Fundus photo; 45° FOV; 2212x1672px:
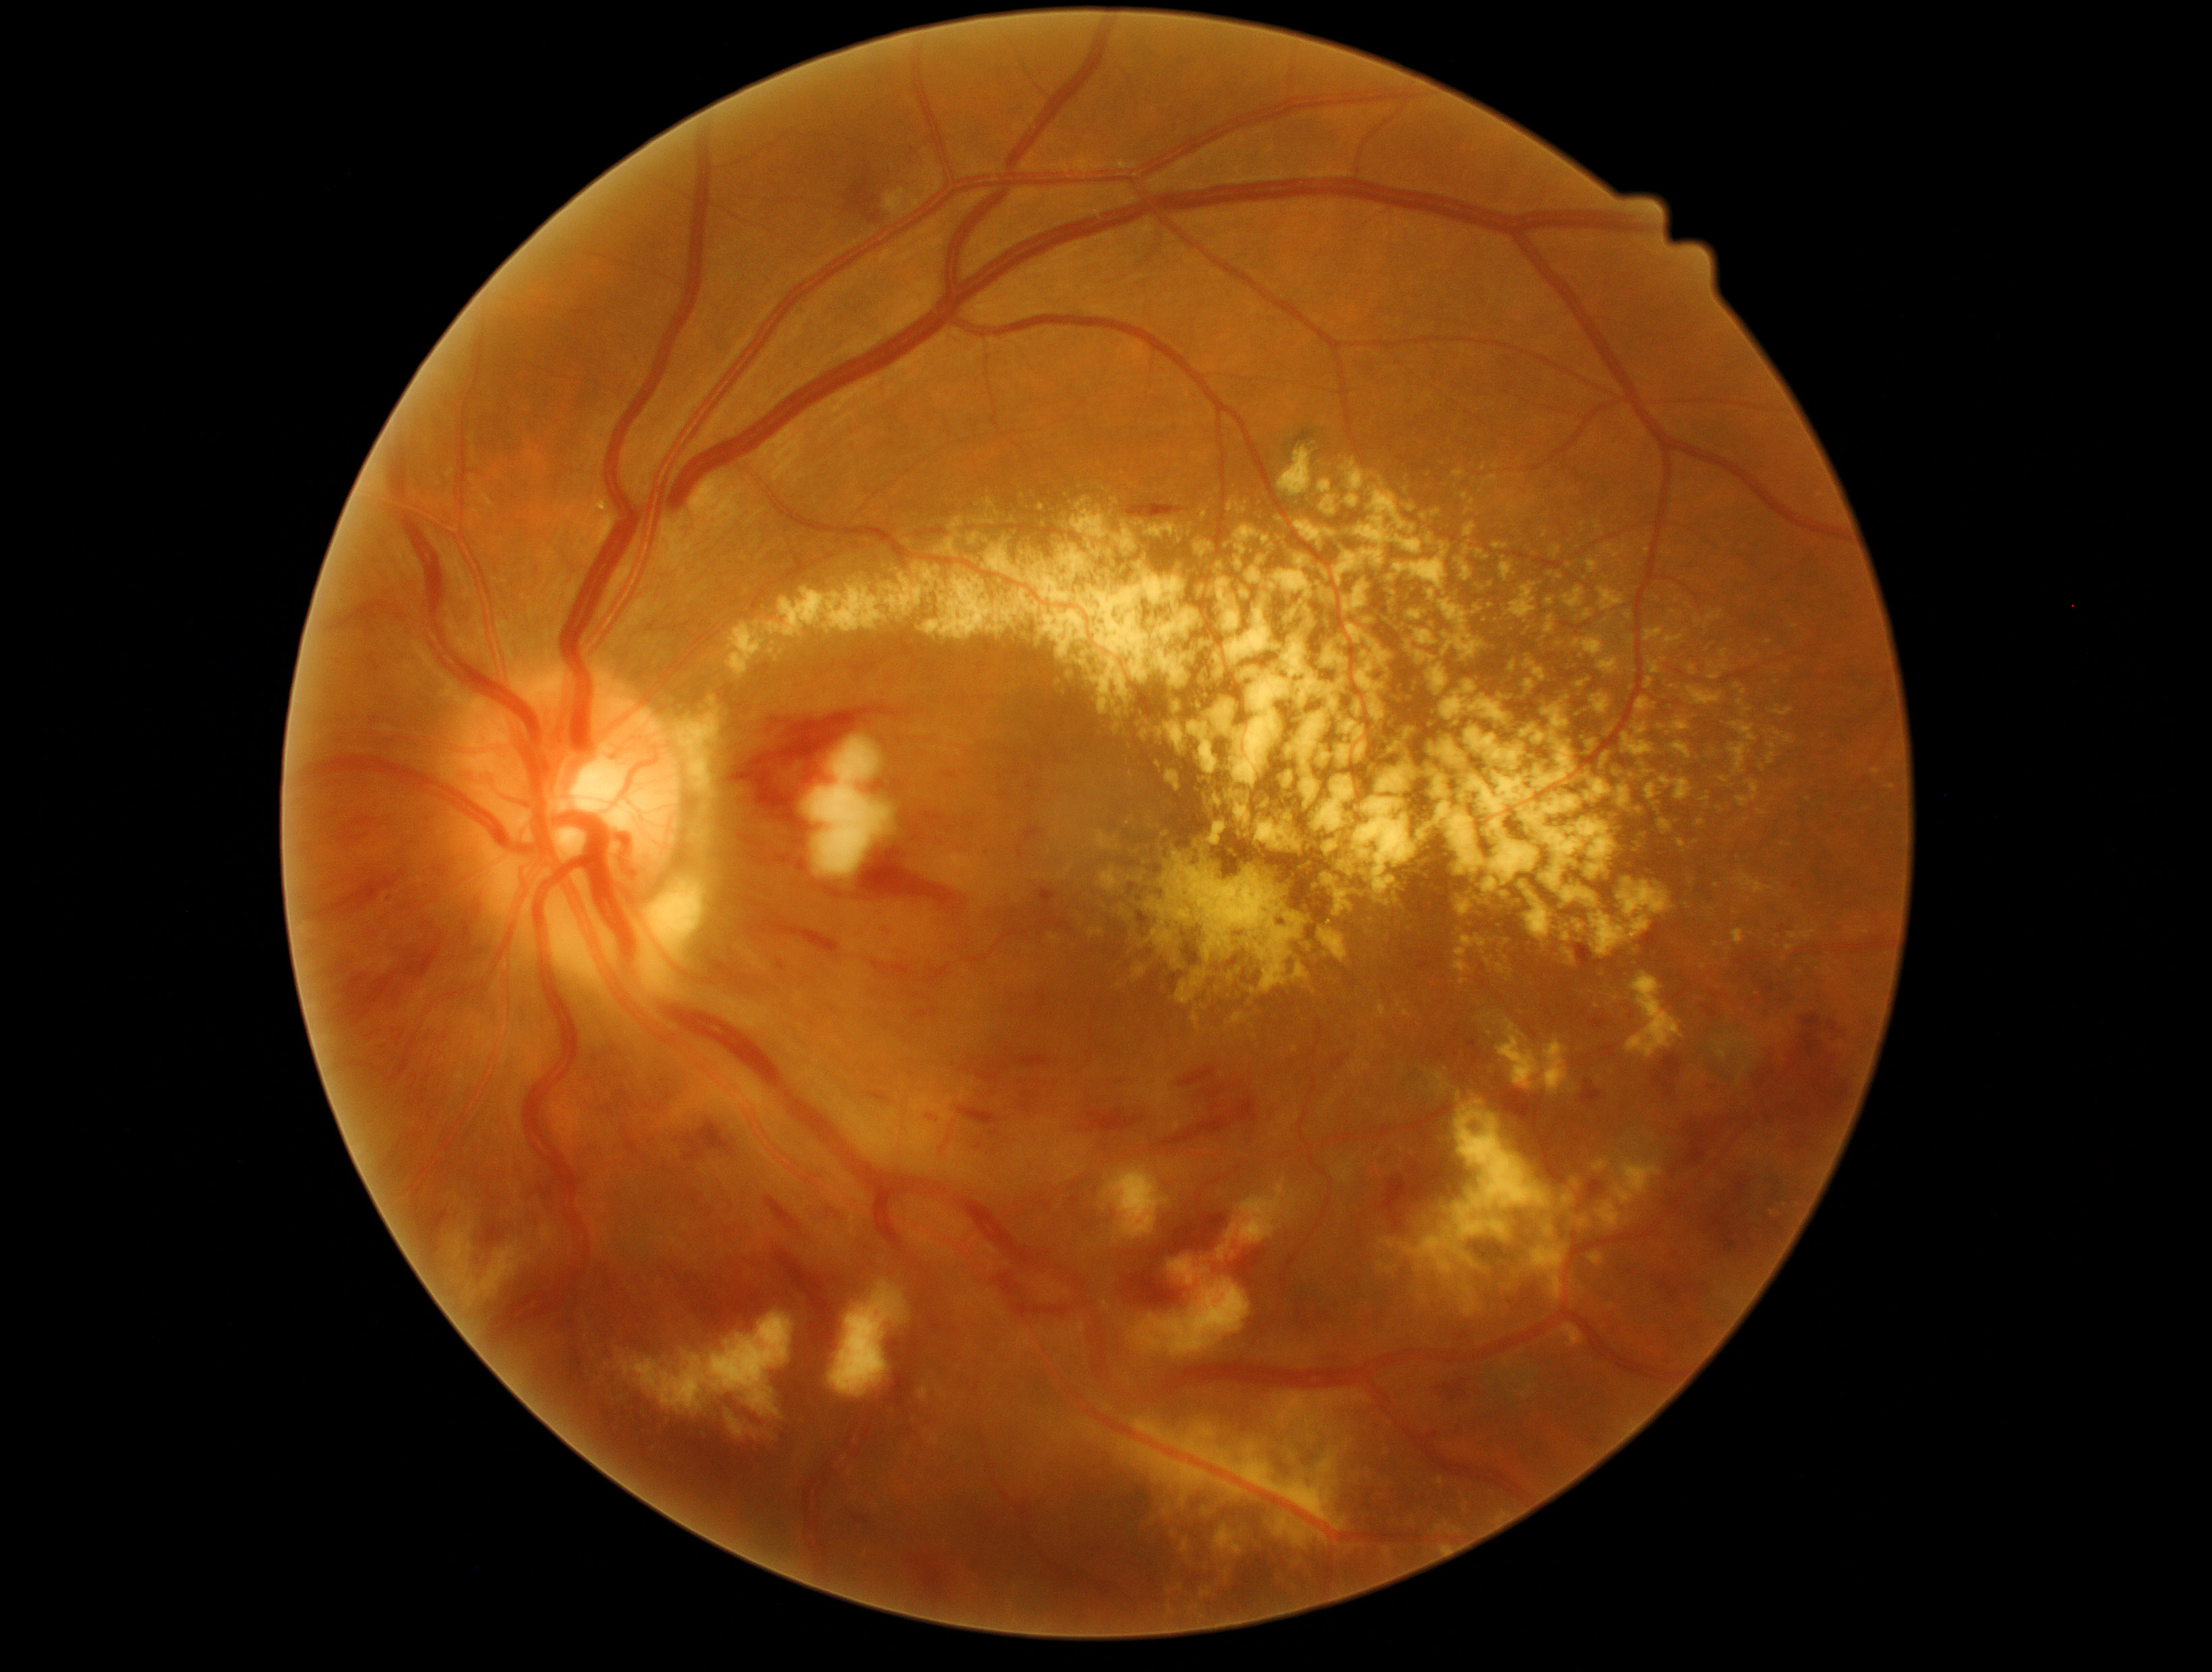

{"partial": true, "dr_grade": 3, "dr_grade_name": "severe NPDR", "lesions": {"ex": [[1459, 548, 1484, 585], [1604, 591, 1631, 613], [1440, 1546, 1449, 1551], [1099, 699, 1108, 715], [1070, 508, 1136, 552], [1165, 1589, 1177, 1627], [1153, 924, 1189, 958], [1472, 580, 1491, 595], [1057, 814, 1076, 831], [1131, 1418, 1347, 1531], [1696, 819, 1703, 831], [1062, 583, 1082, 593], [1058, 865, 1074, 880], [1197, 509, 1208, 518], [1309, 873, 1354, 918], [1532, 1193, 1590, 1303], [1411, 629, 1447, 649]], "ex_small": [[1749, 901], [1778, 736], [1613, 1179]]}}